45° FOV.
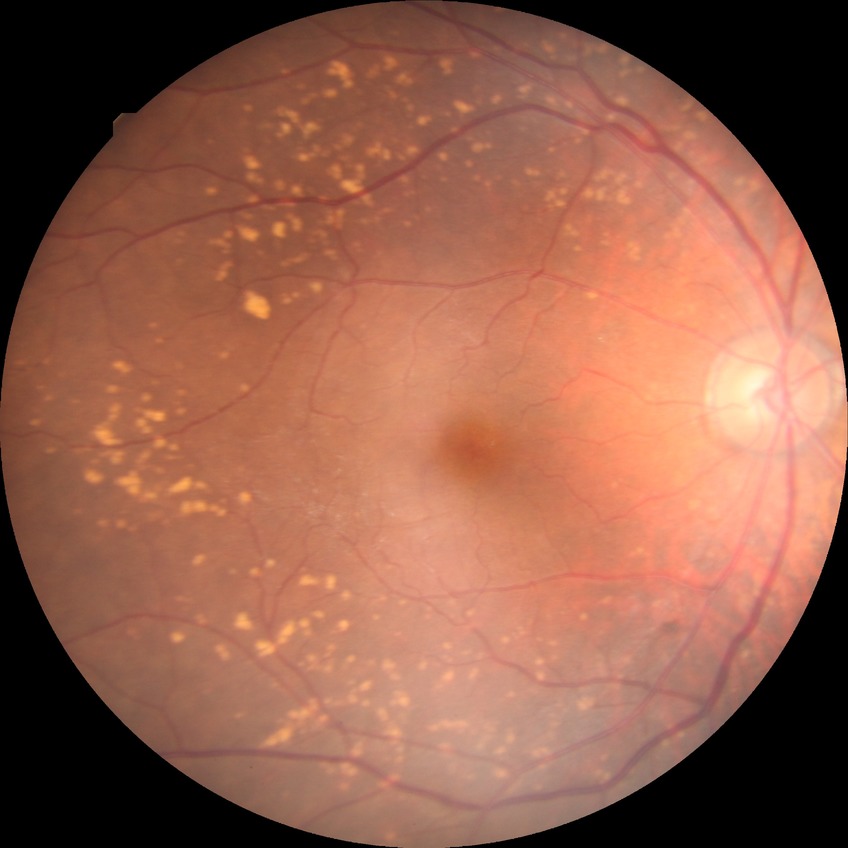

Davis DR grade is SDR.